2352x1568px: 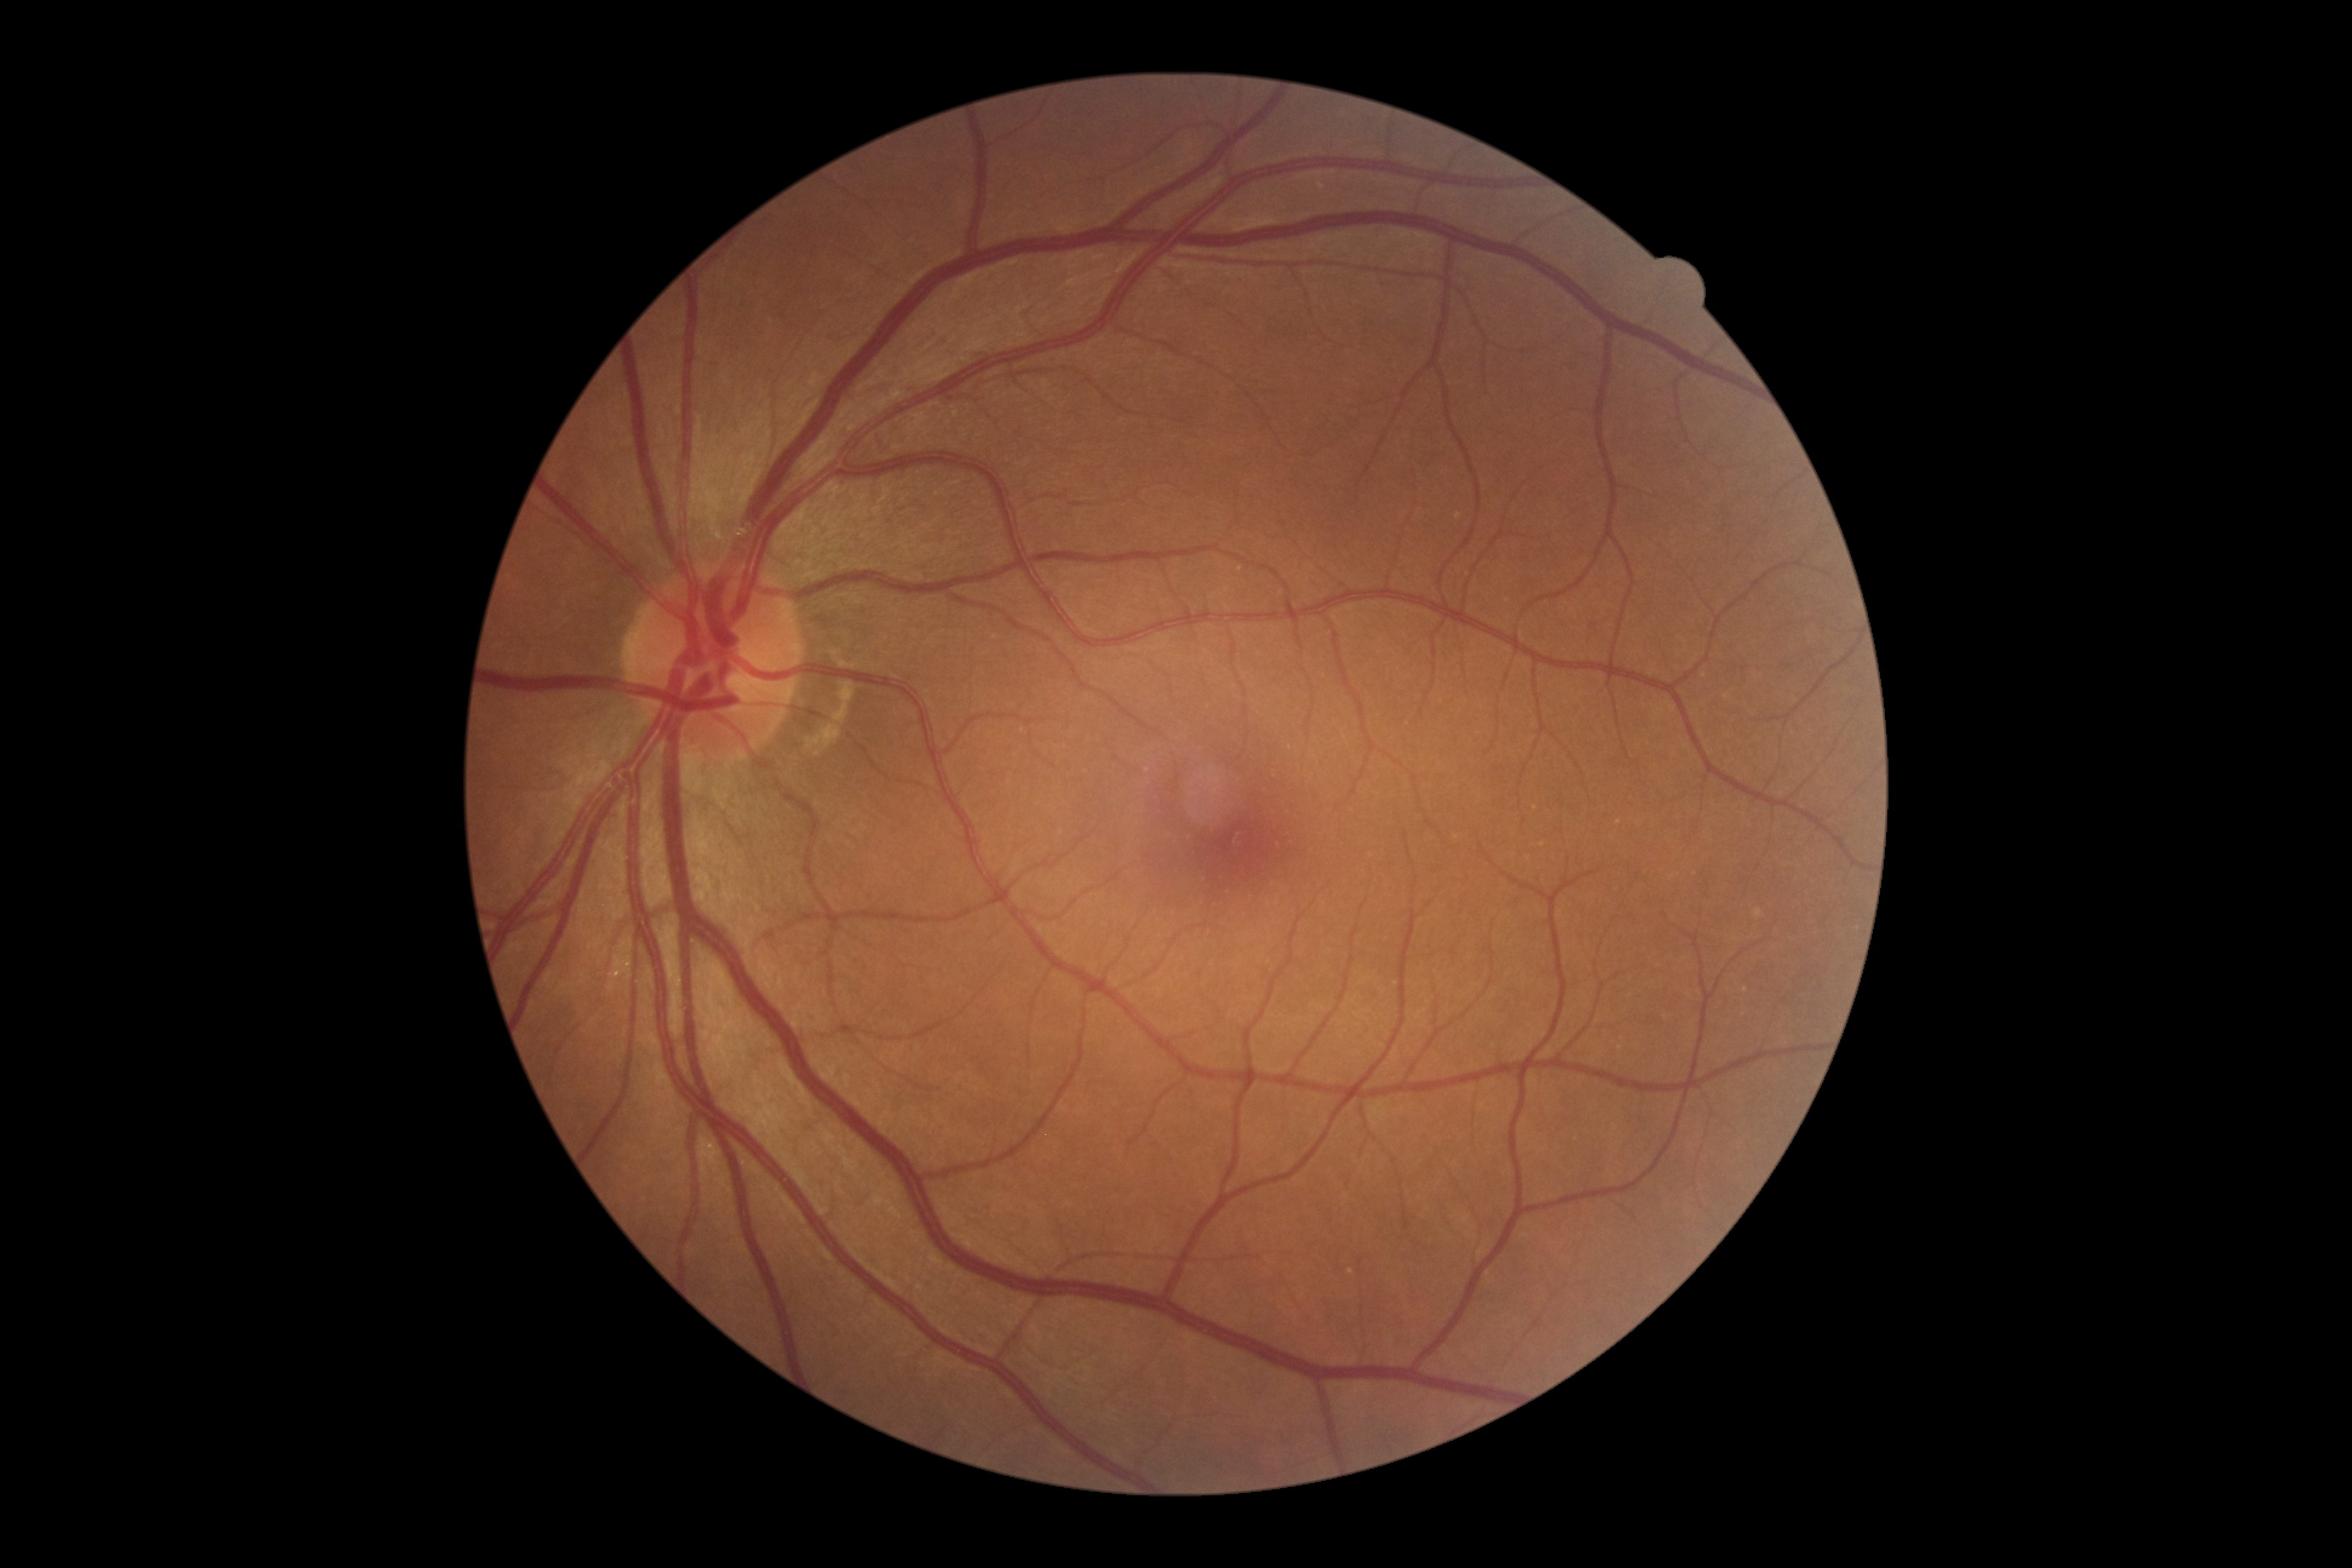 Diabetic retinopathy severity: no apparent diabetic retinopathy (grade 0).